Modified Davis grading.
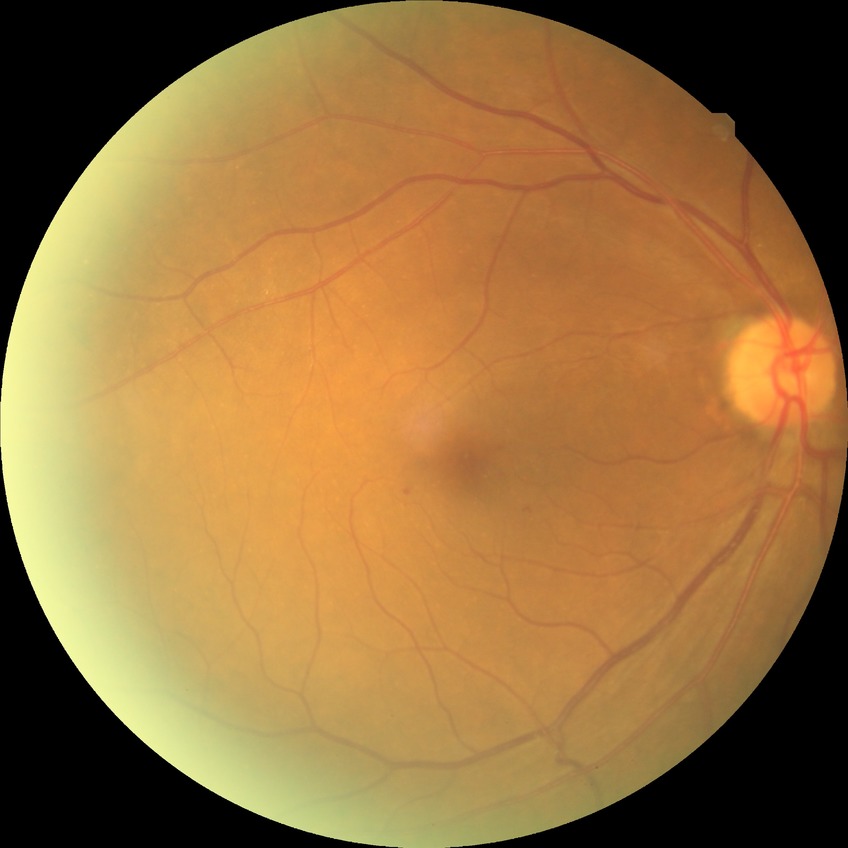 Diabetic retinopathy (DR): simple diabetic retinopathy (SDR).